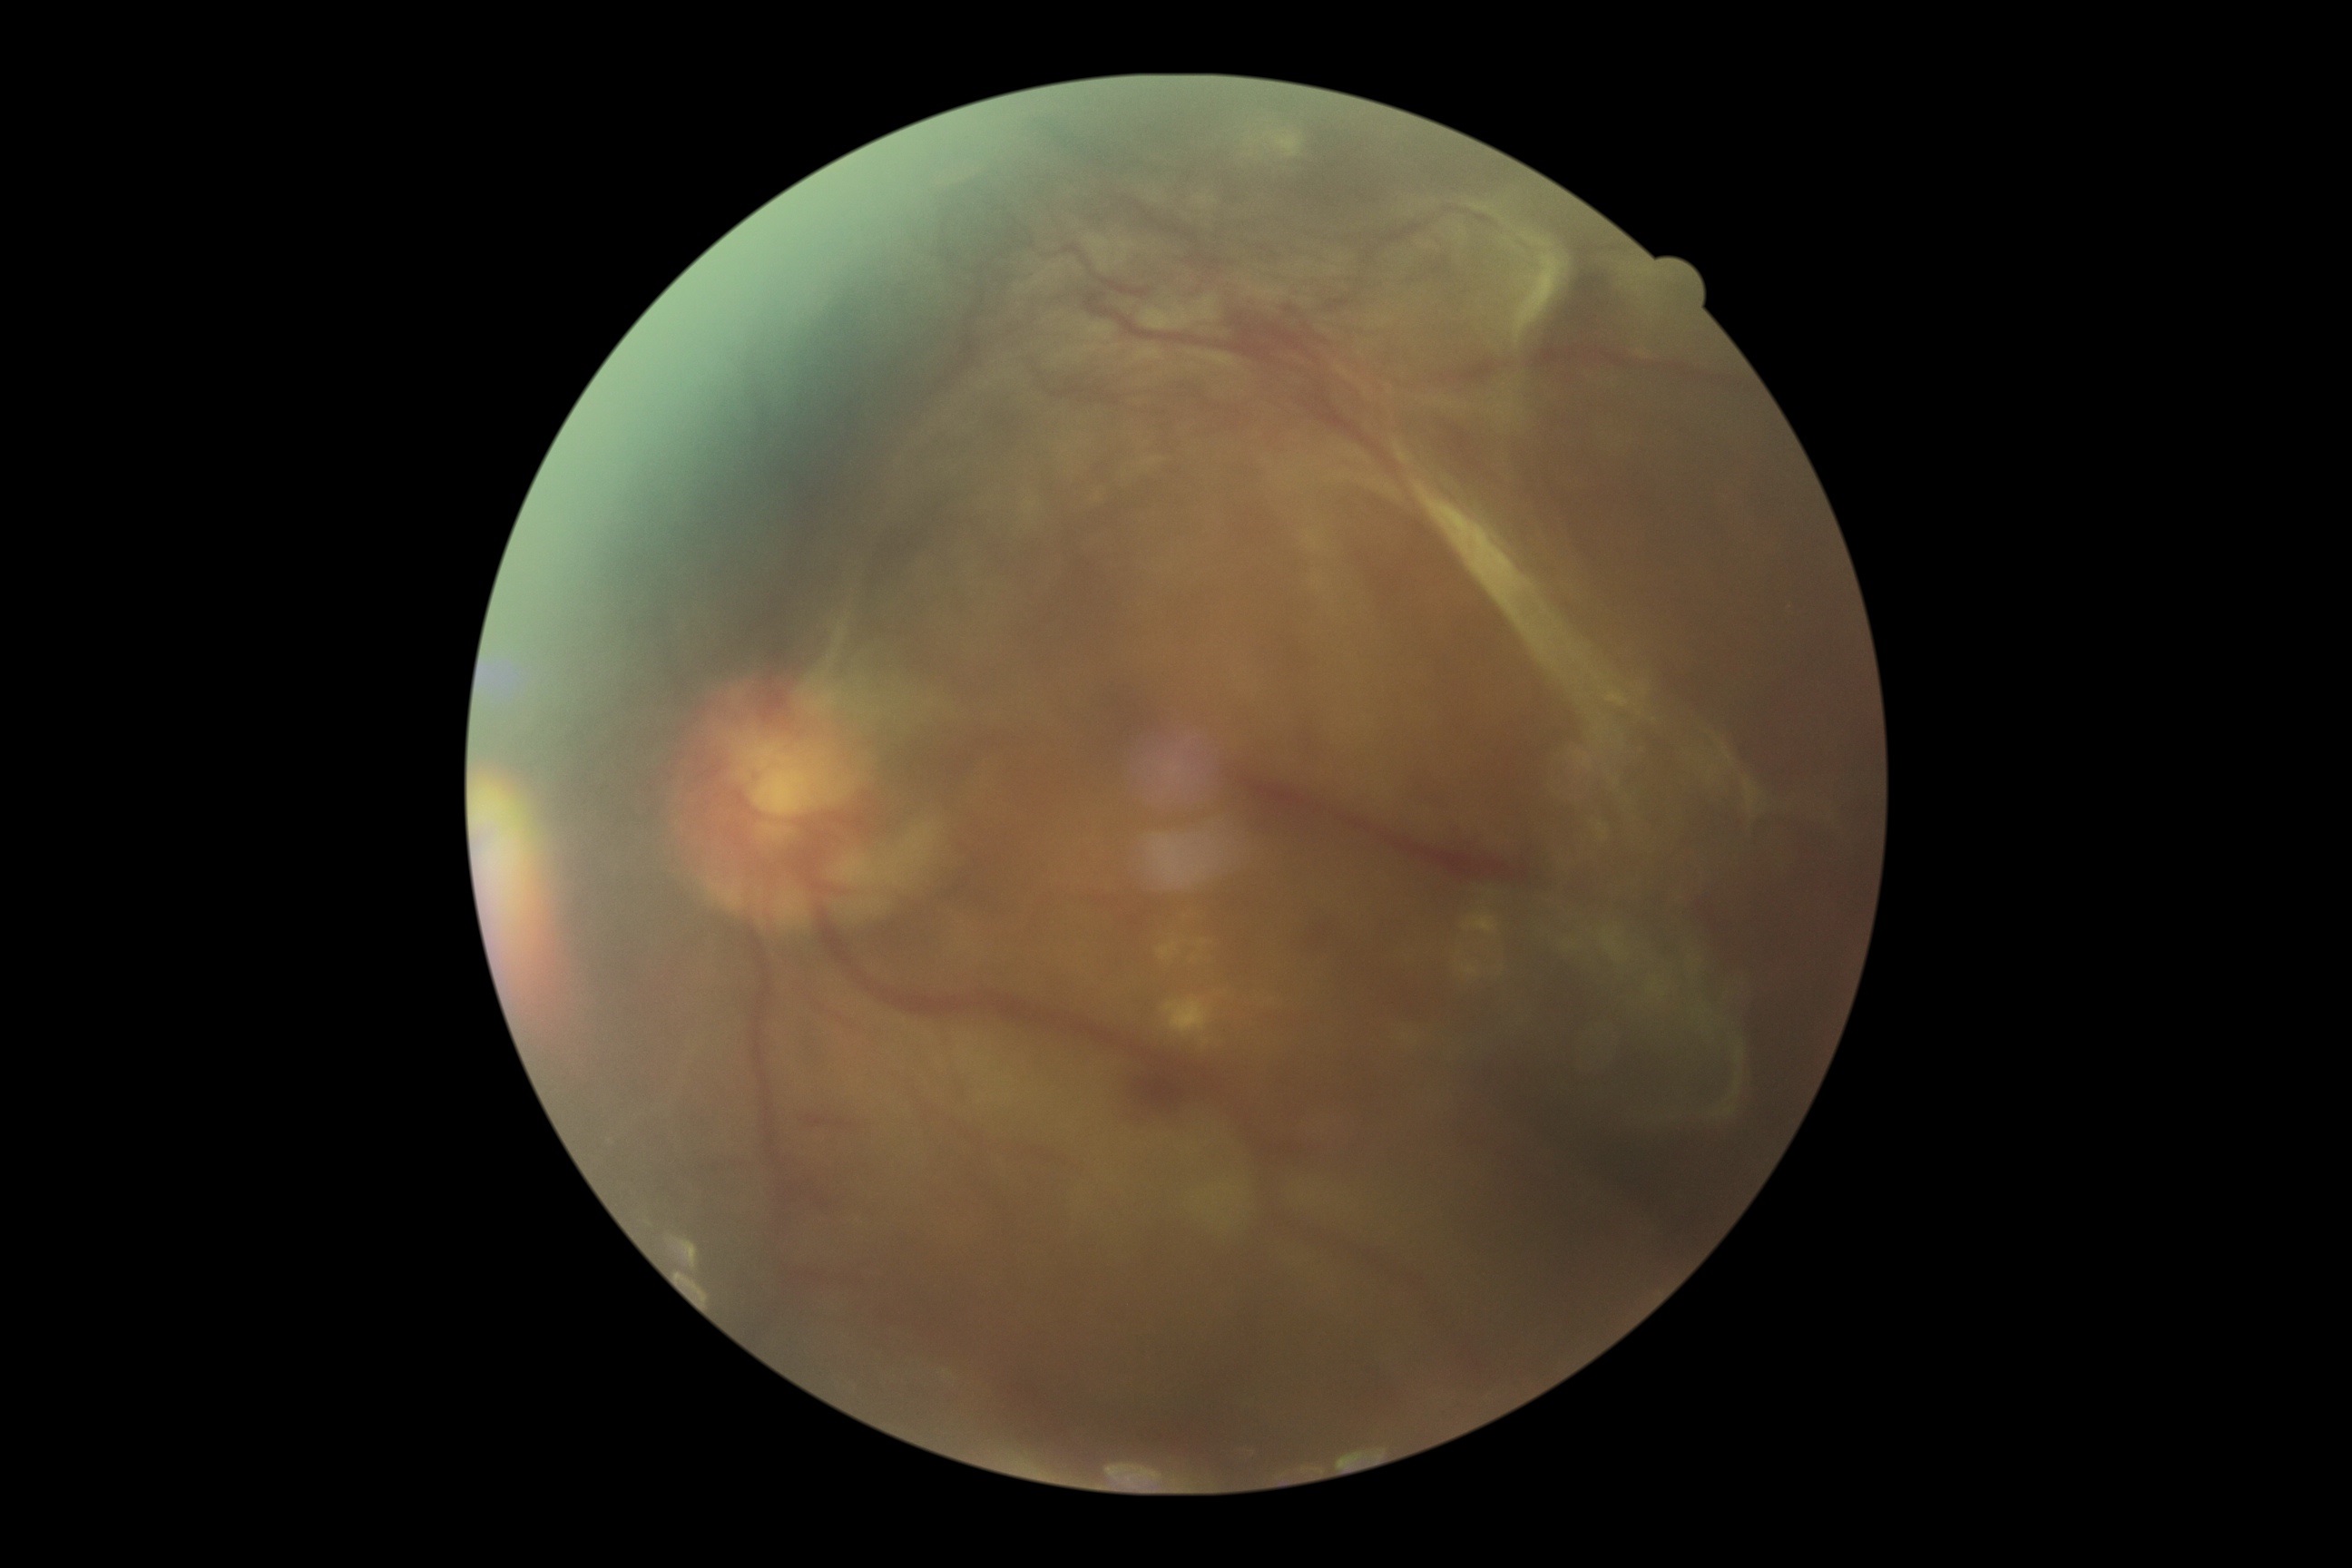 DR grade = proliferative diabetic retinopathy (4)
DR class = proliferative diabetic retinopathy